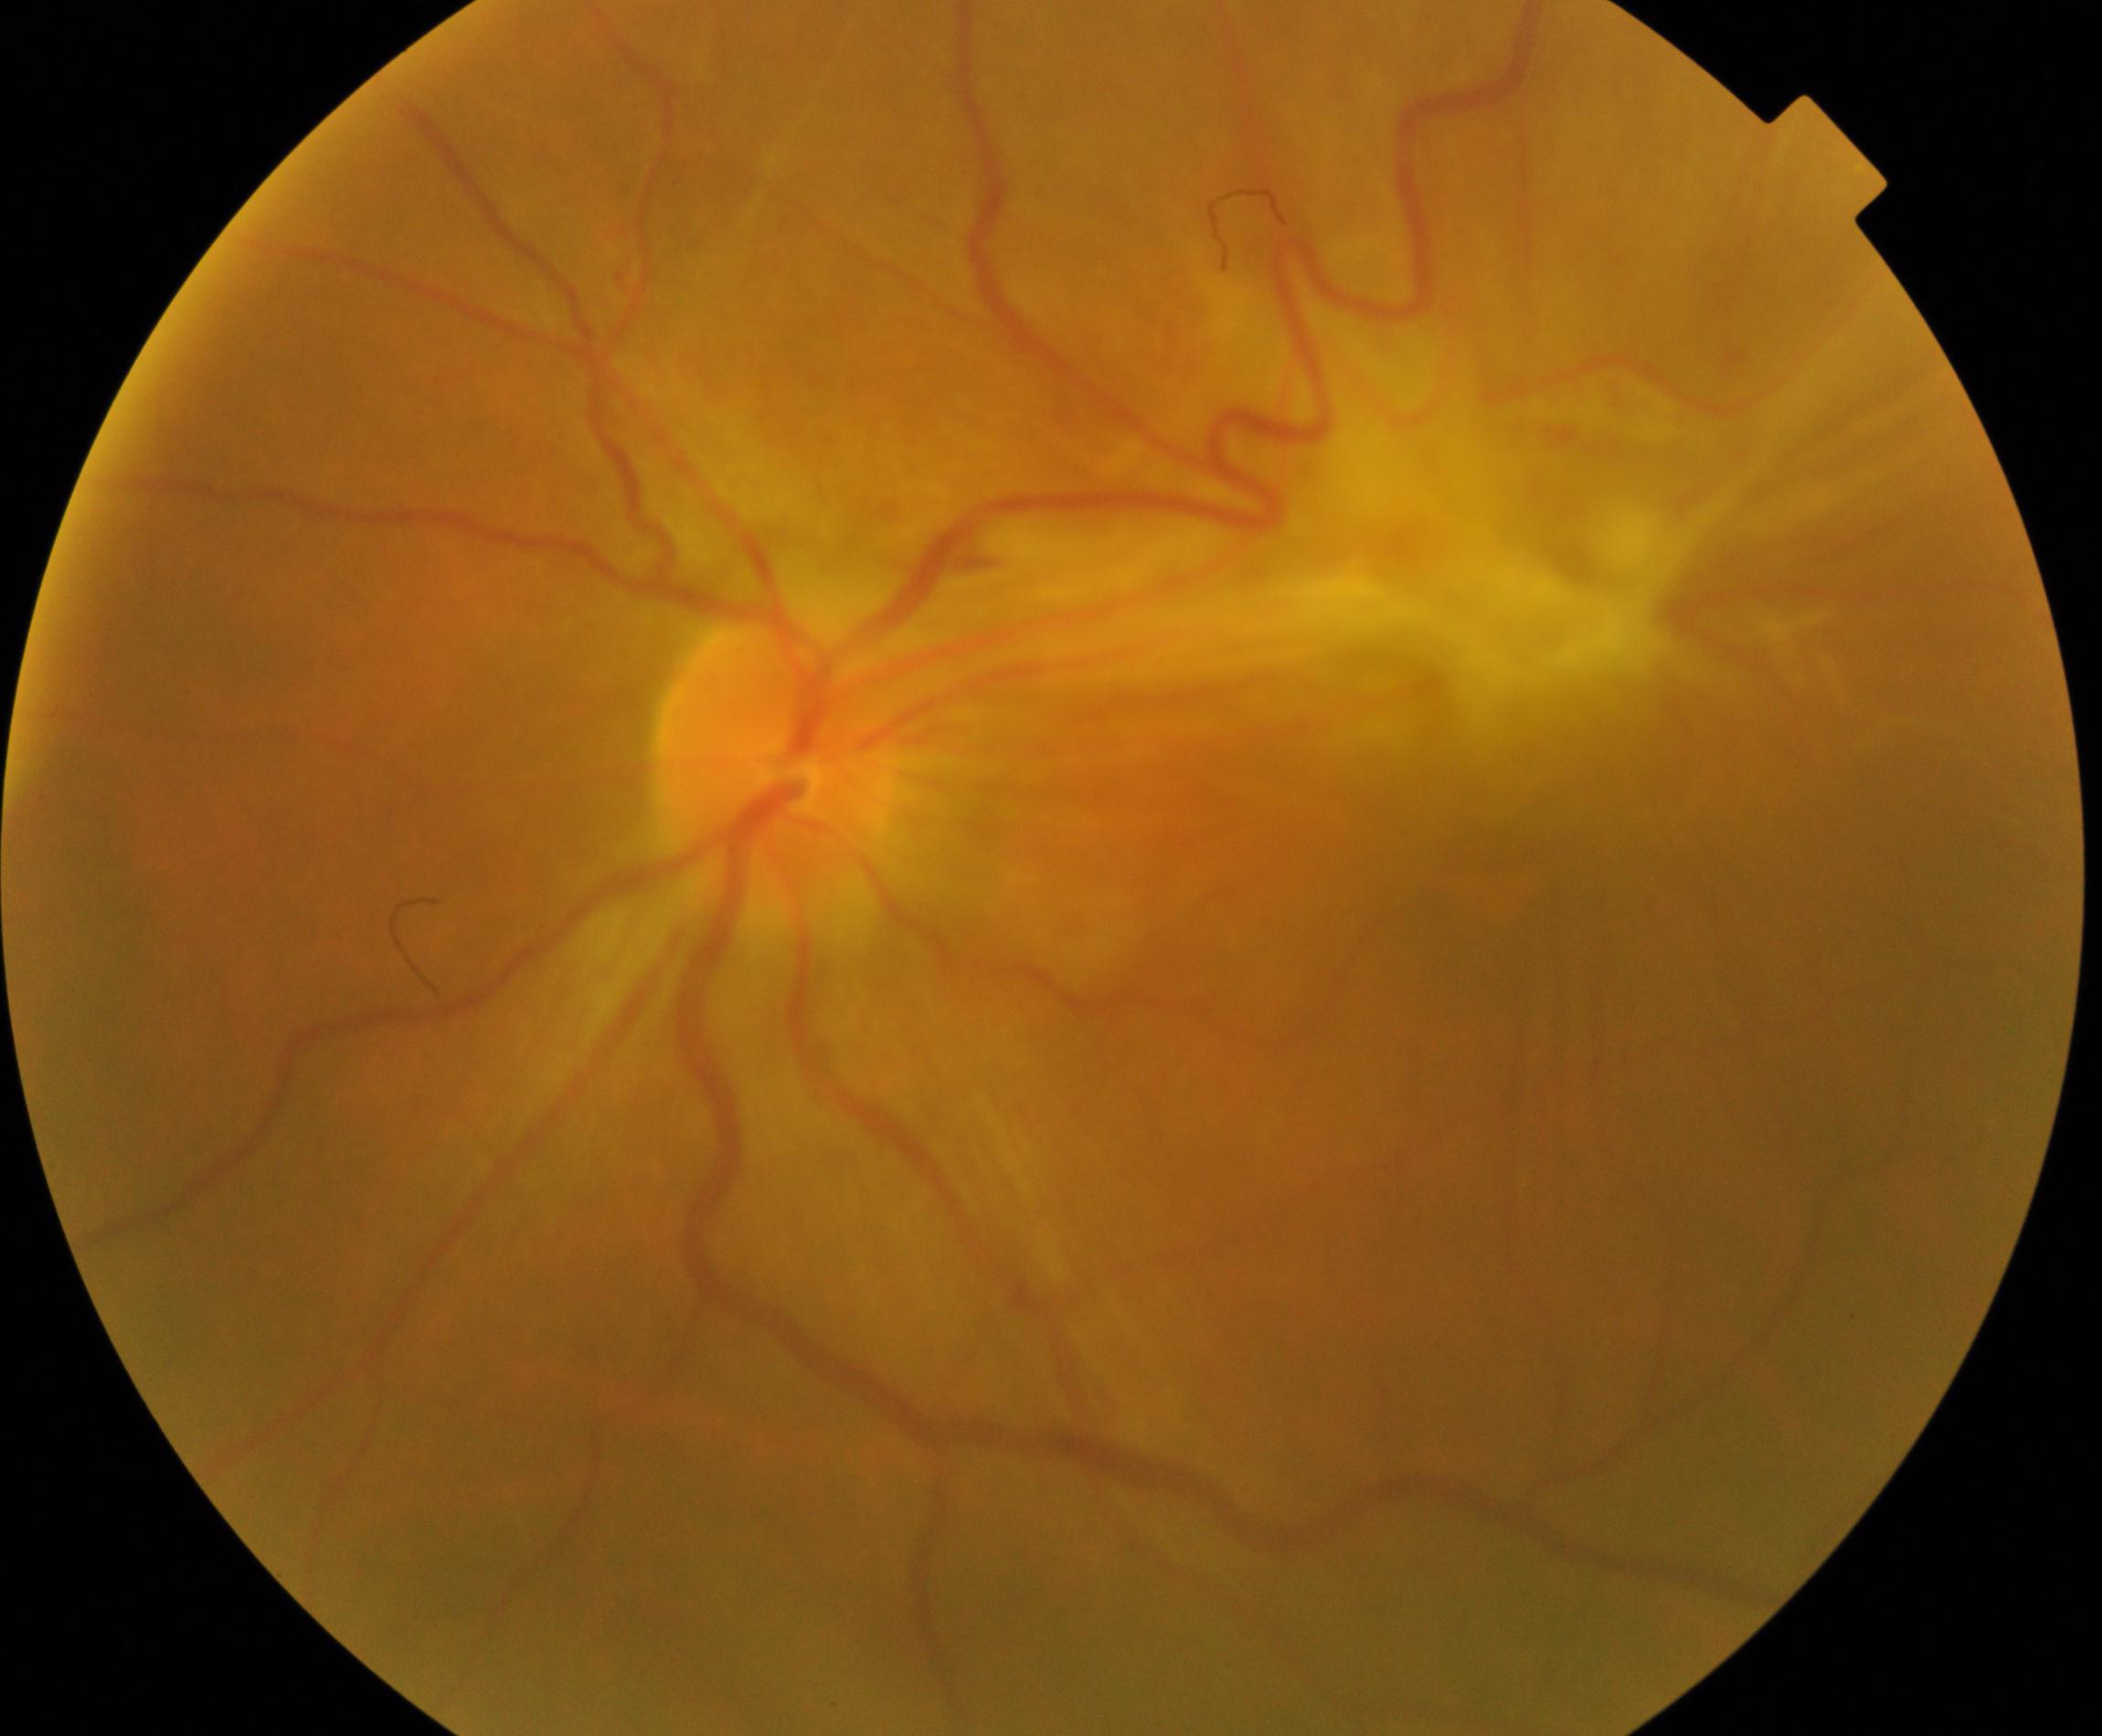

There is evidence of fibrosis.